Infant wide-field retinal image · 1440 by 1080 pixels
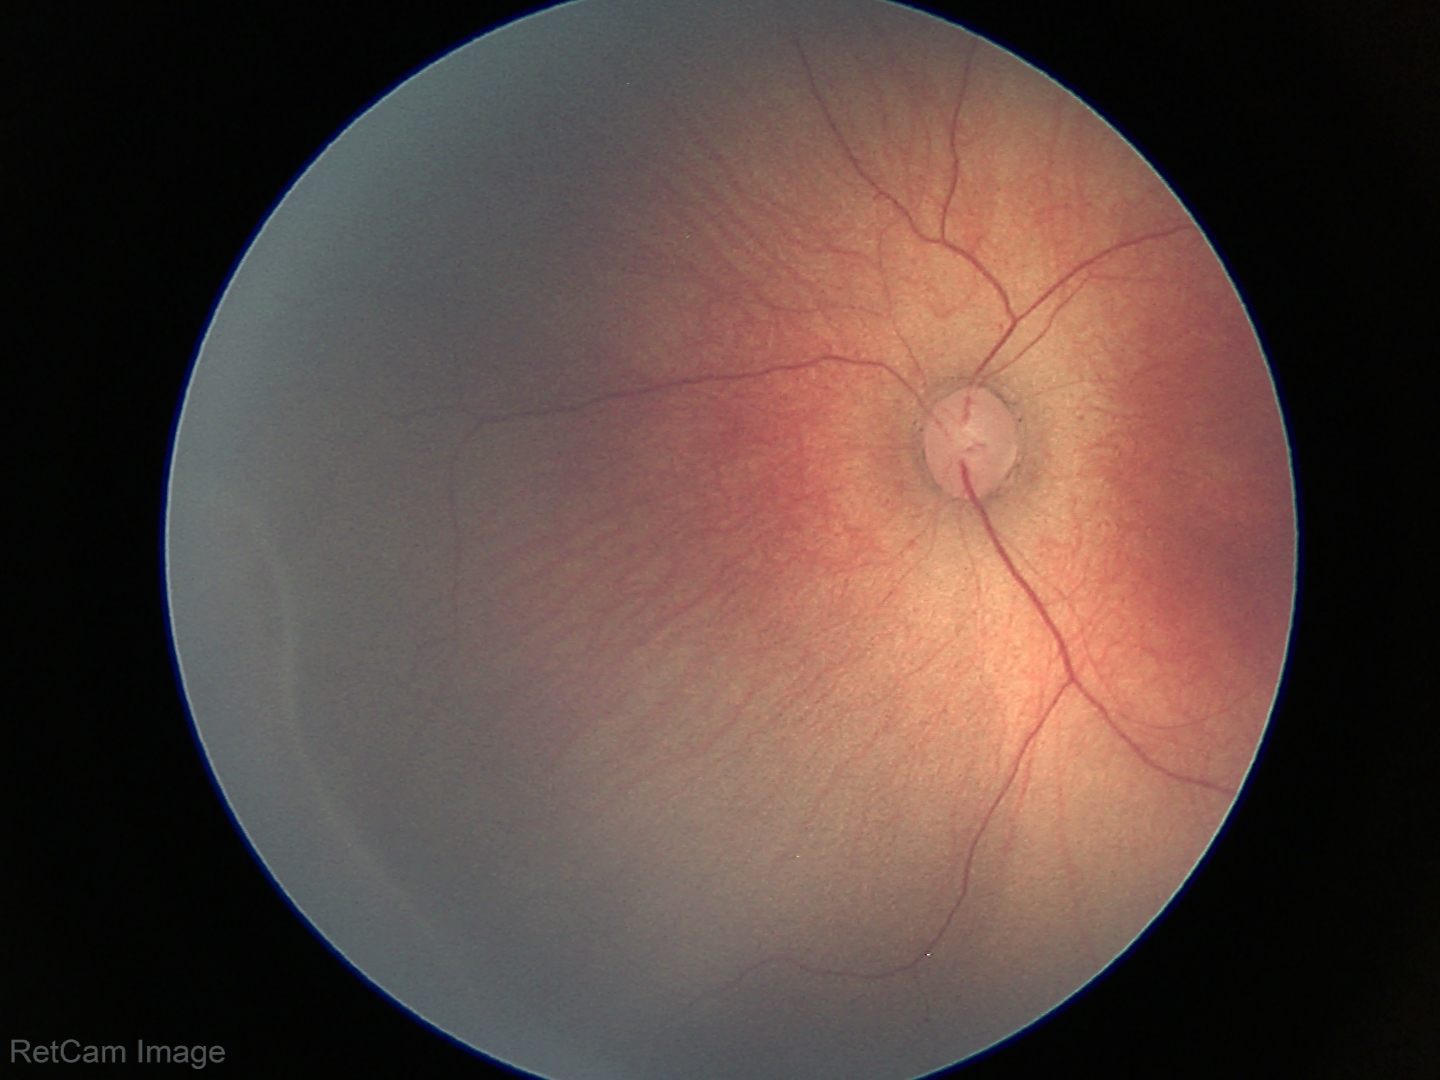

Plus disease = absent | retinopathy of prematurity (ROP) stage = 2.